Pediatric retinal photograph (wide-field): 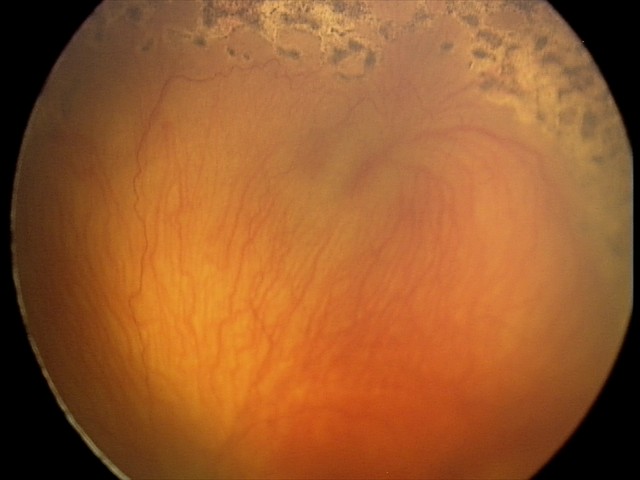
From an examination with diagnosis of aggressive retinopathy of prematurity.